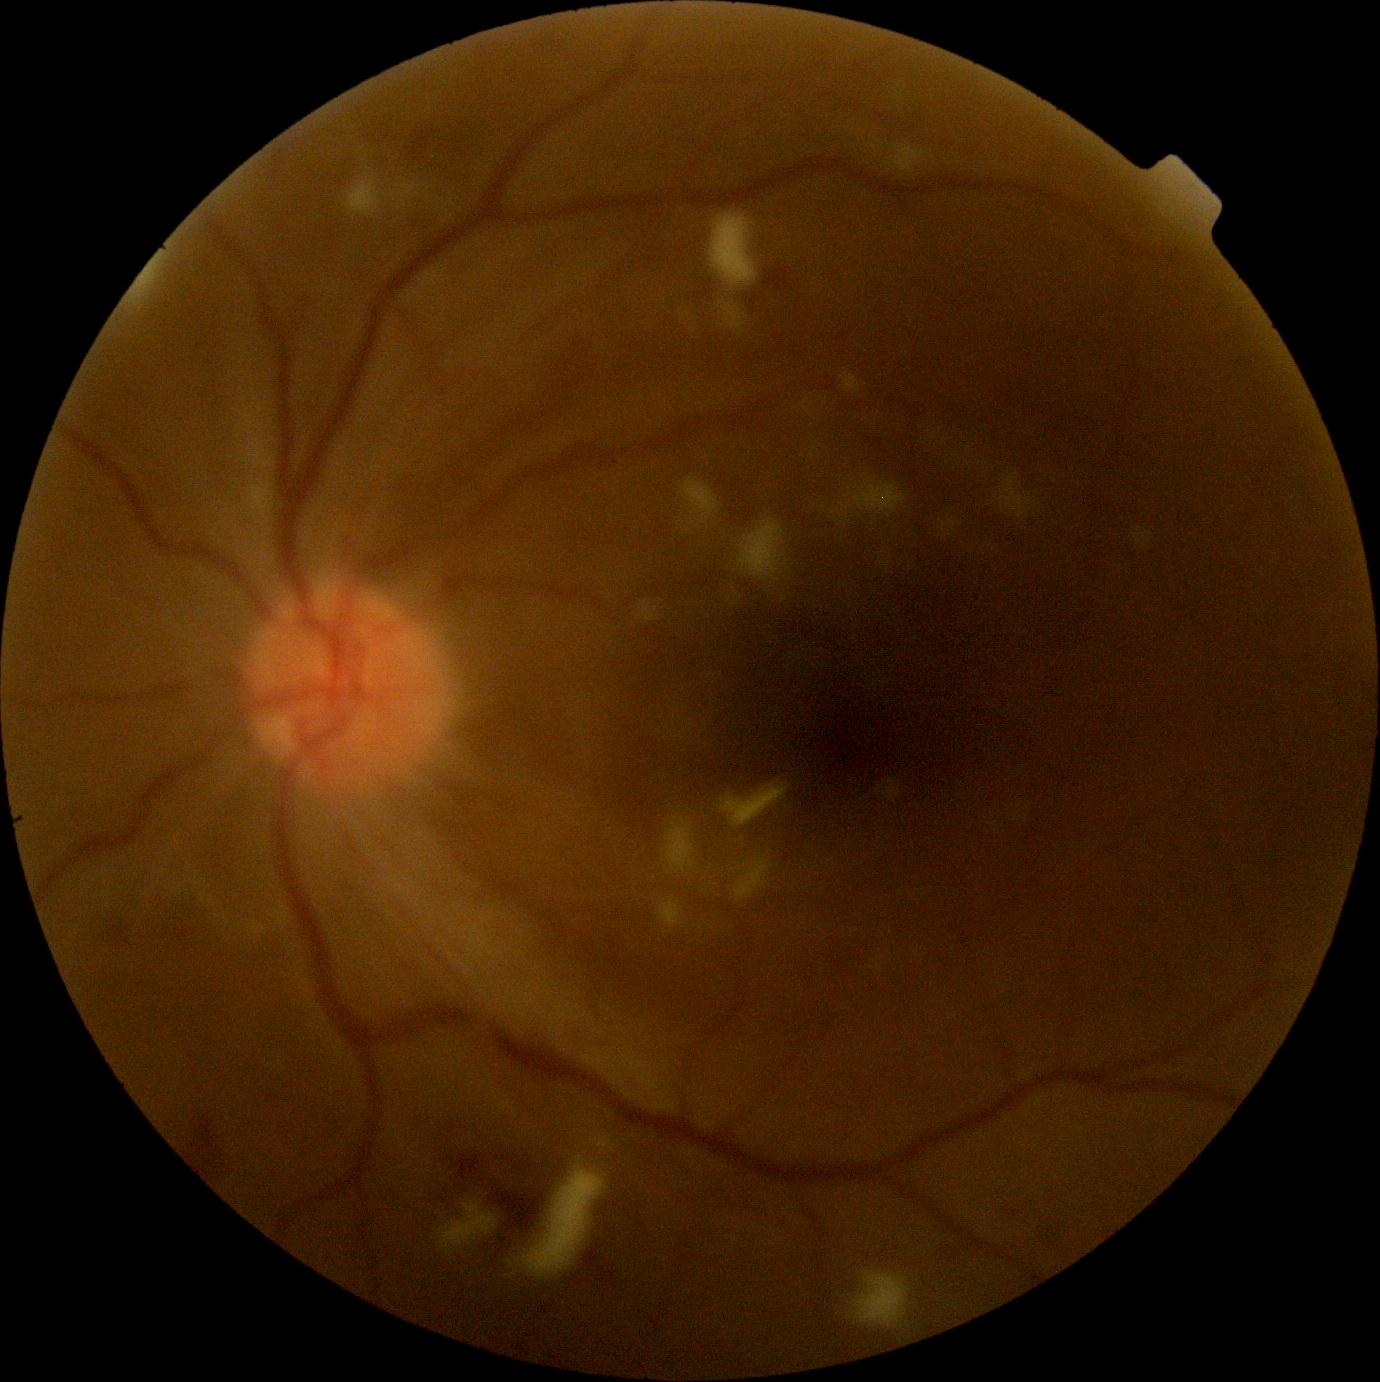

  dr_grade: grade 2
  dr_category: non-proliferative diabetic retinopathy